Wide-field fundus image from infant ROP screening; image size 640x480.
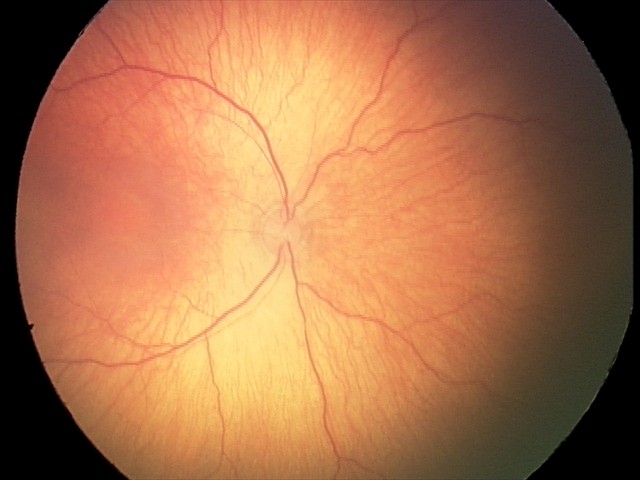 Examination diagnosed as ROP stage 1 — demarcation line between vascular and avascular retina.